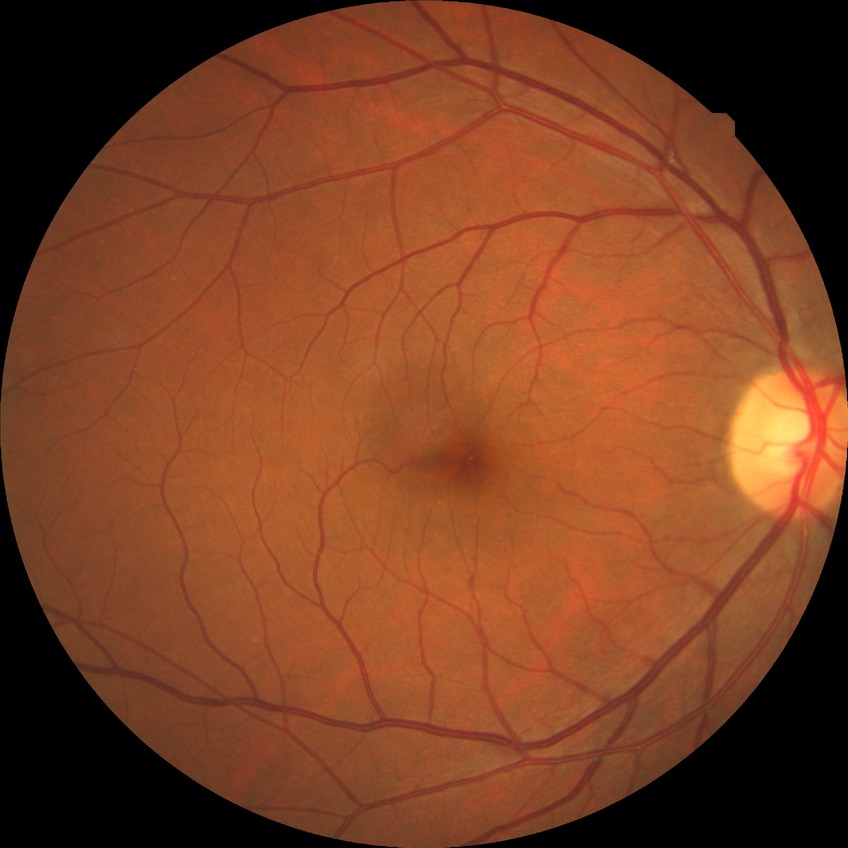

diabetic retinopathy (DR)=no diabetic retinopathy (NDR).